45° field of view, 2350x1568:
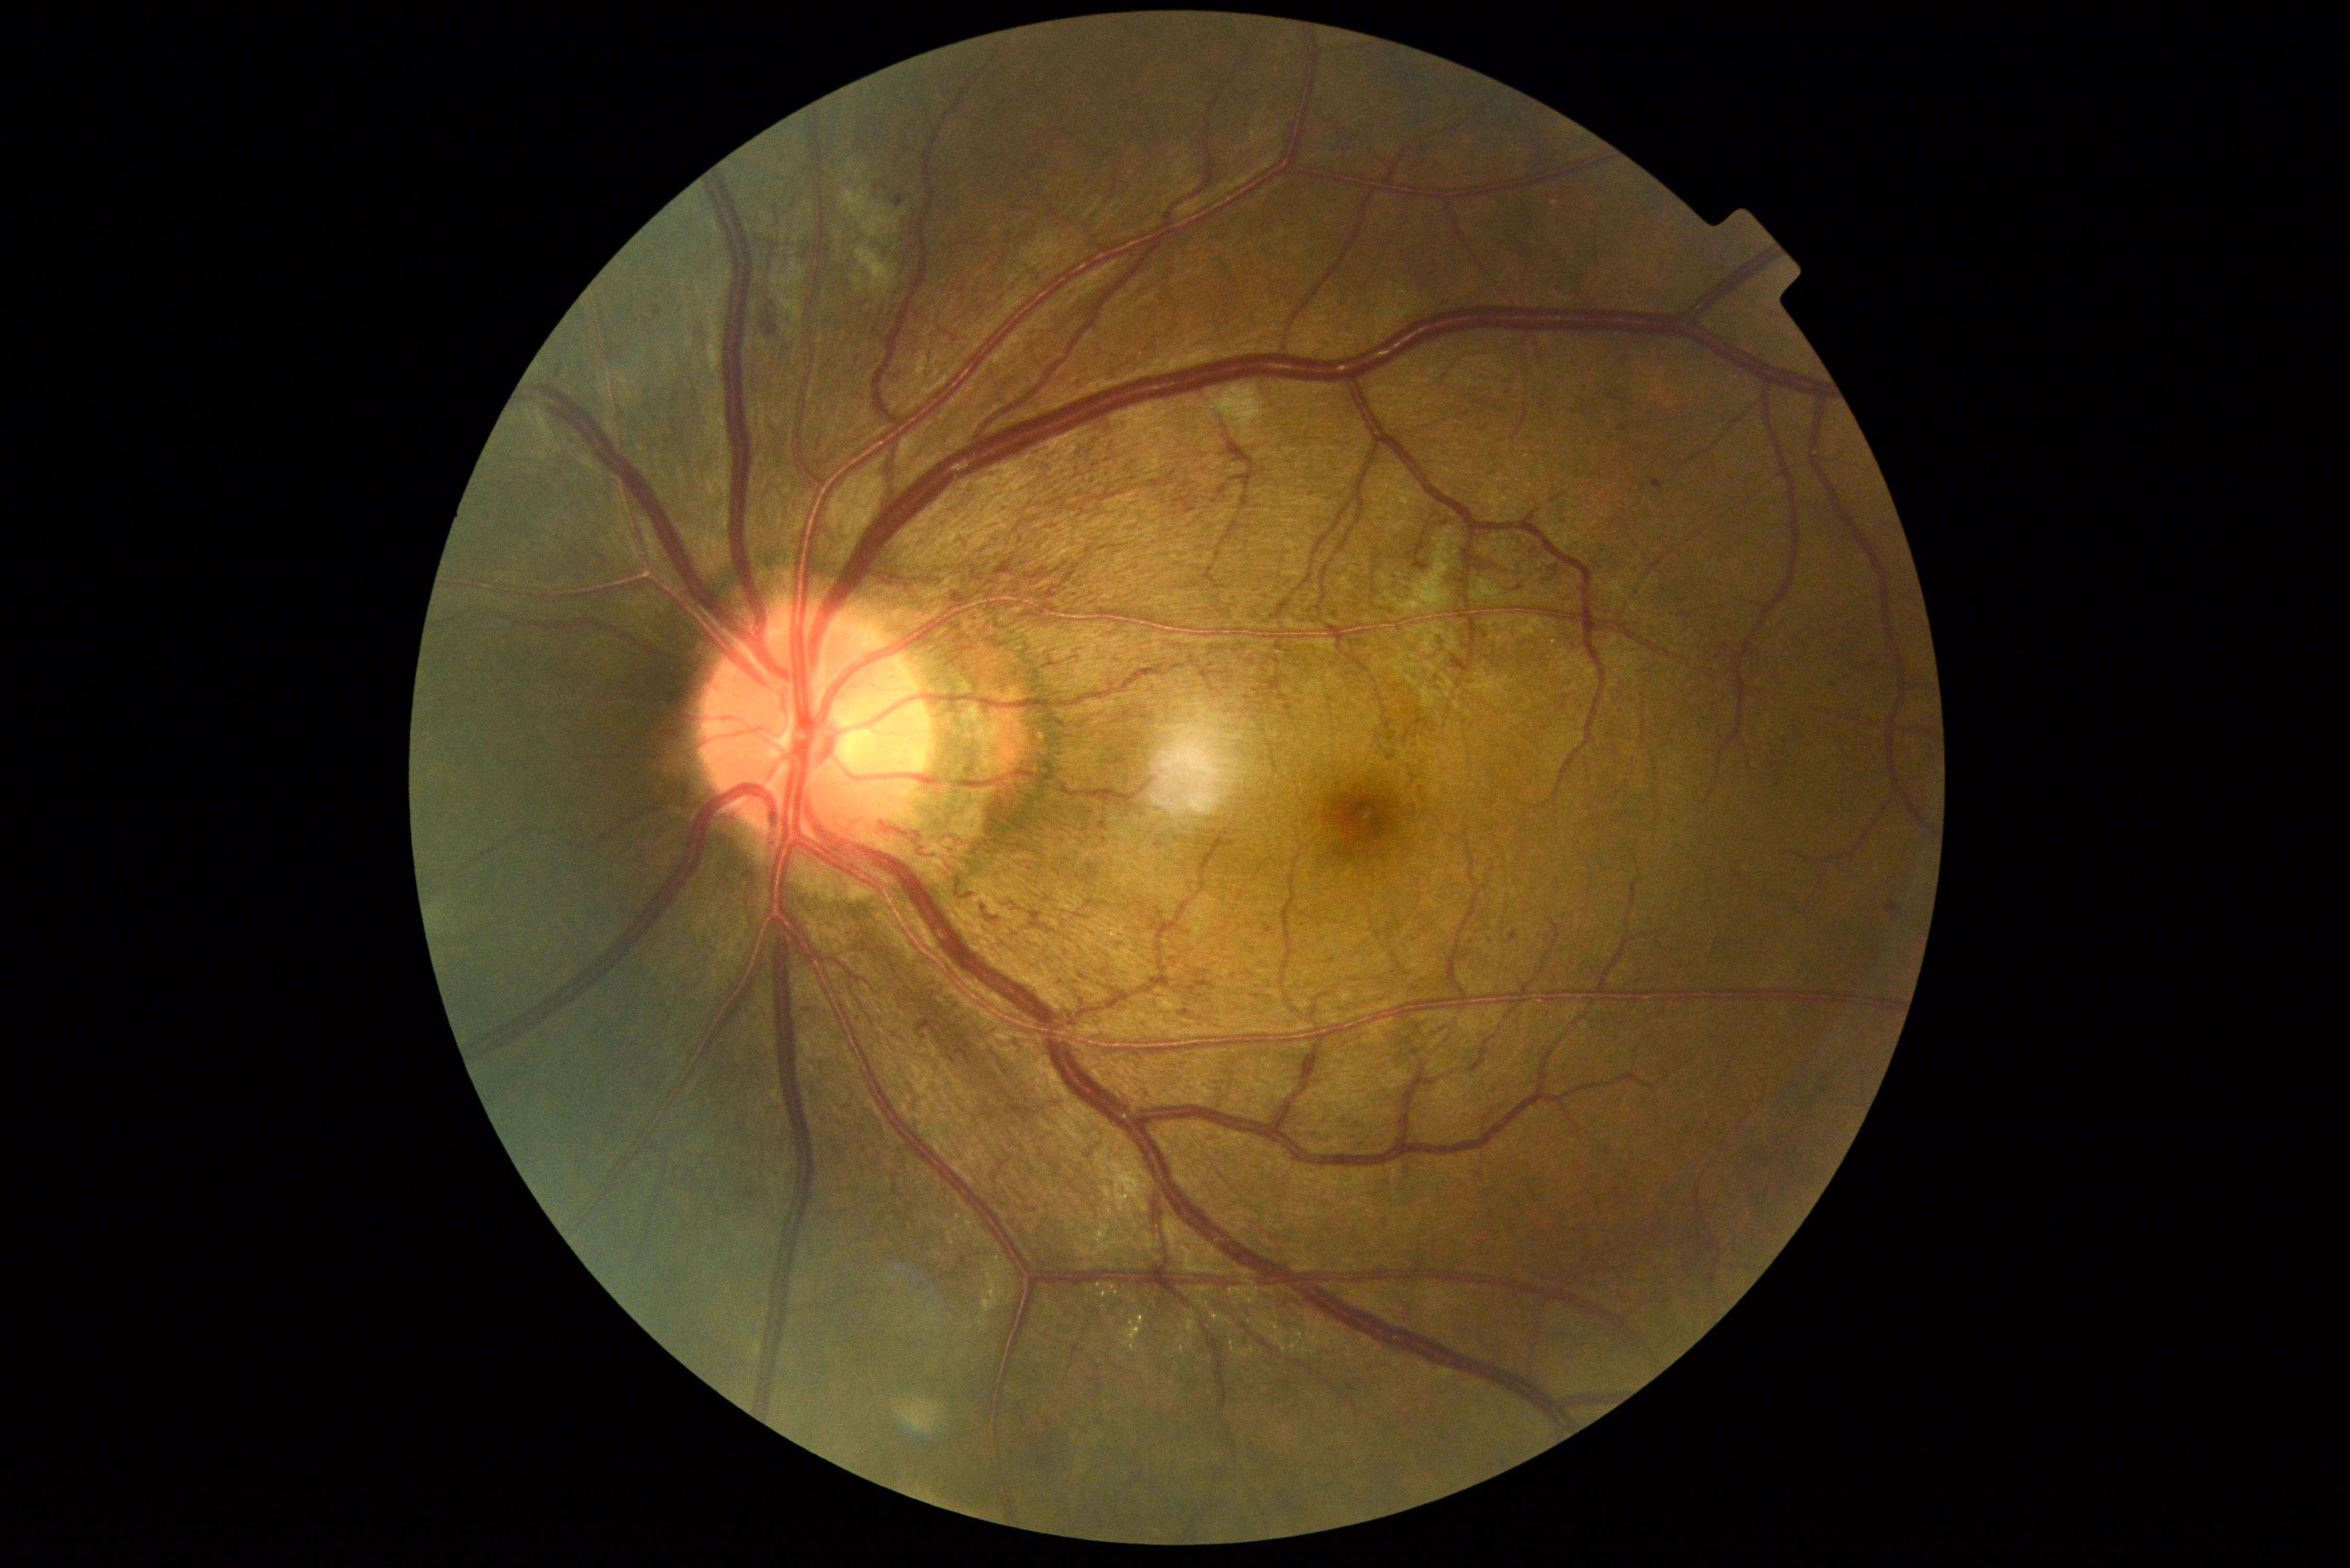
DR severity: 2/4